Image size 848x848. Posterior pole color fundus photograph. NIDEK AFC-230 fundus camera. 45° FOV — 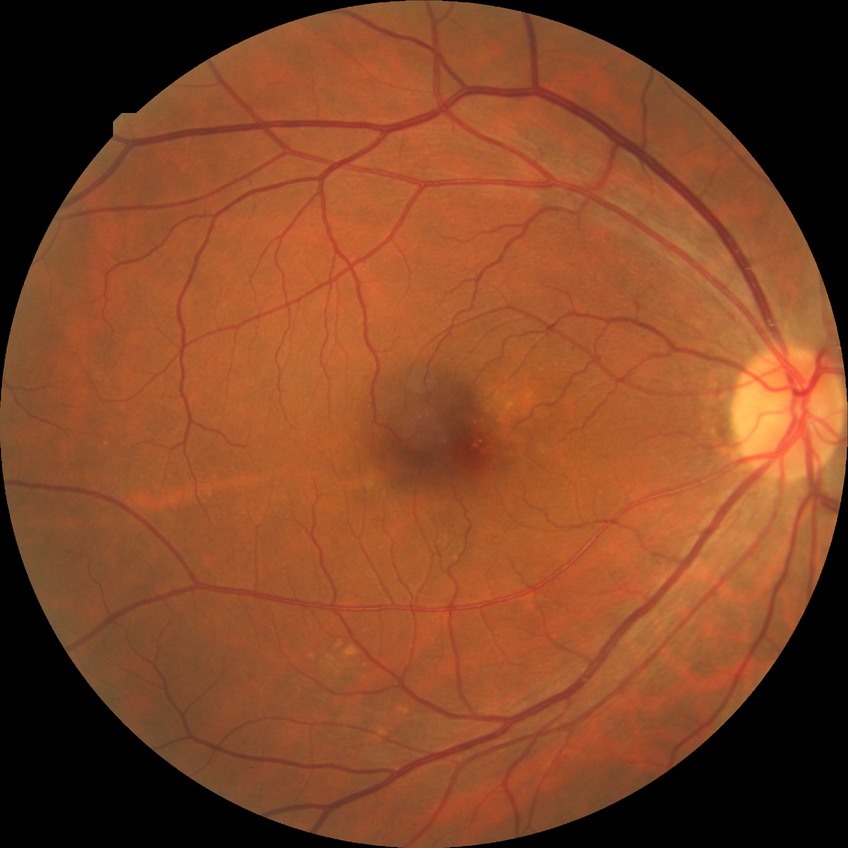
Modified Davis classification is no diabetic retinopathy.